2352x1568:
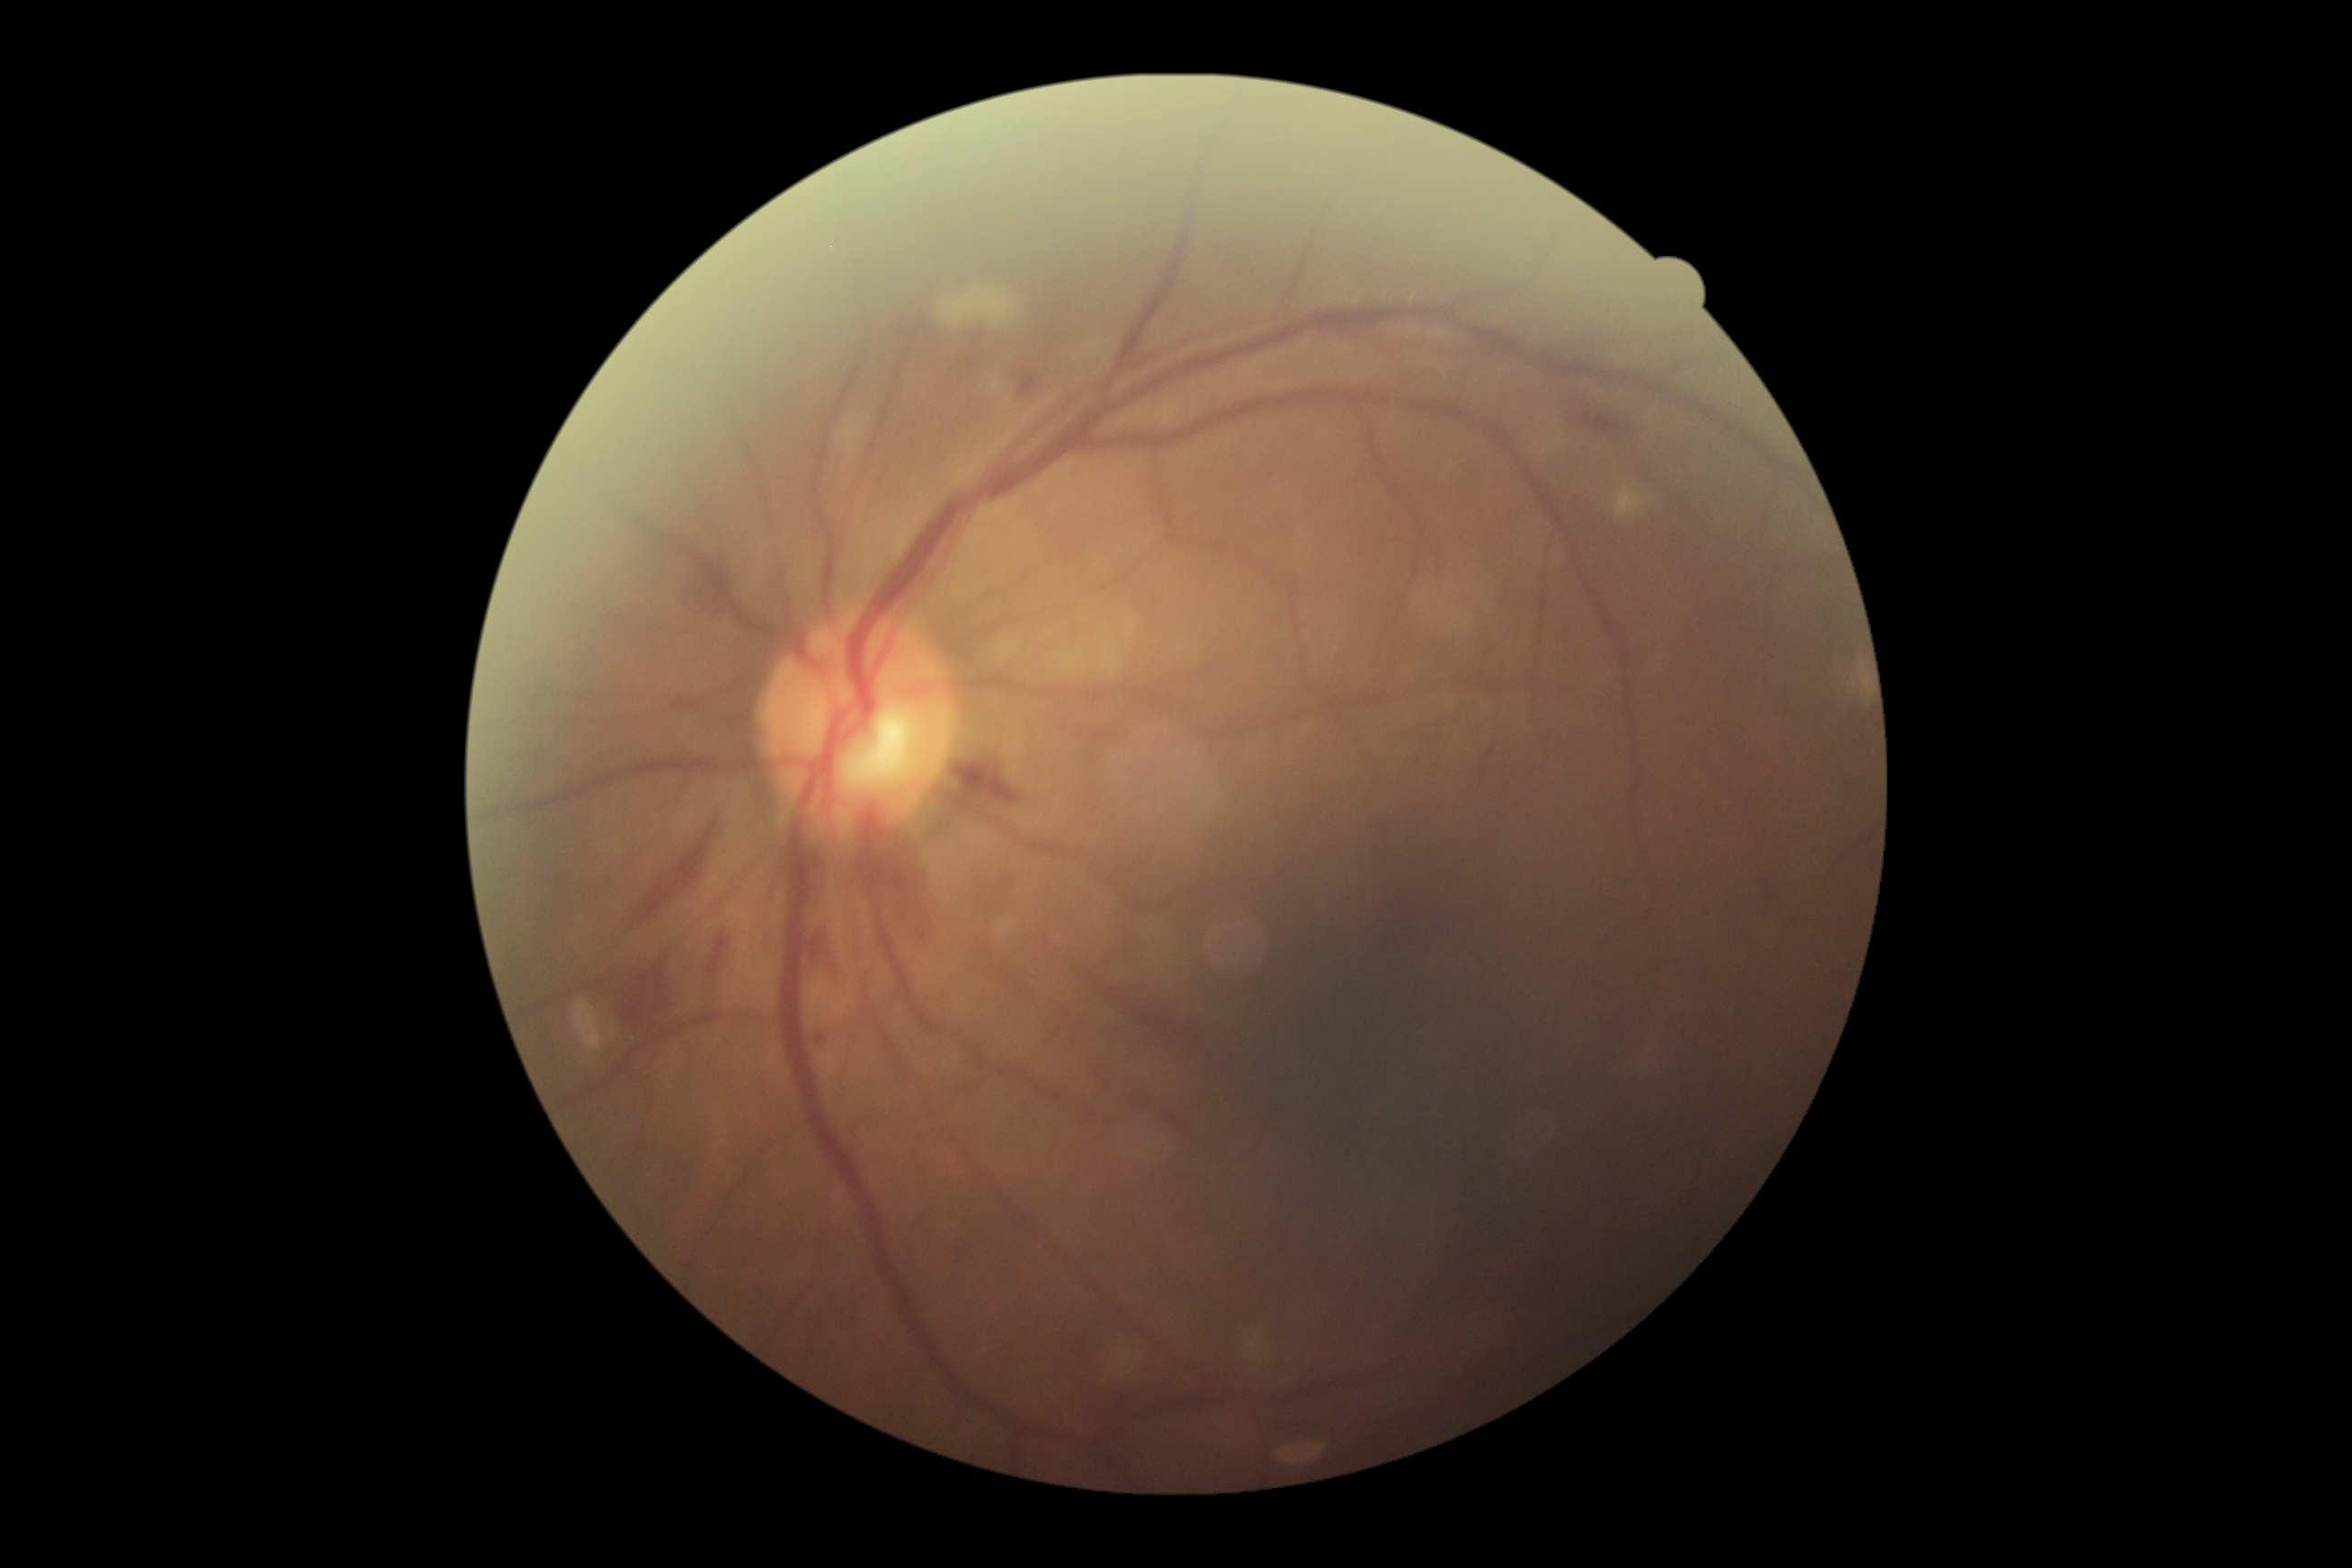 DR class: non-proliferative diabetic retinopathy. DR severity is grade 2.